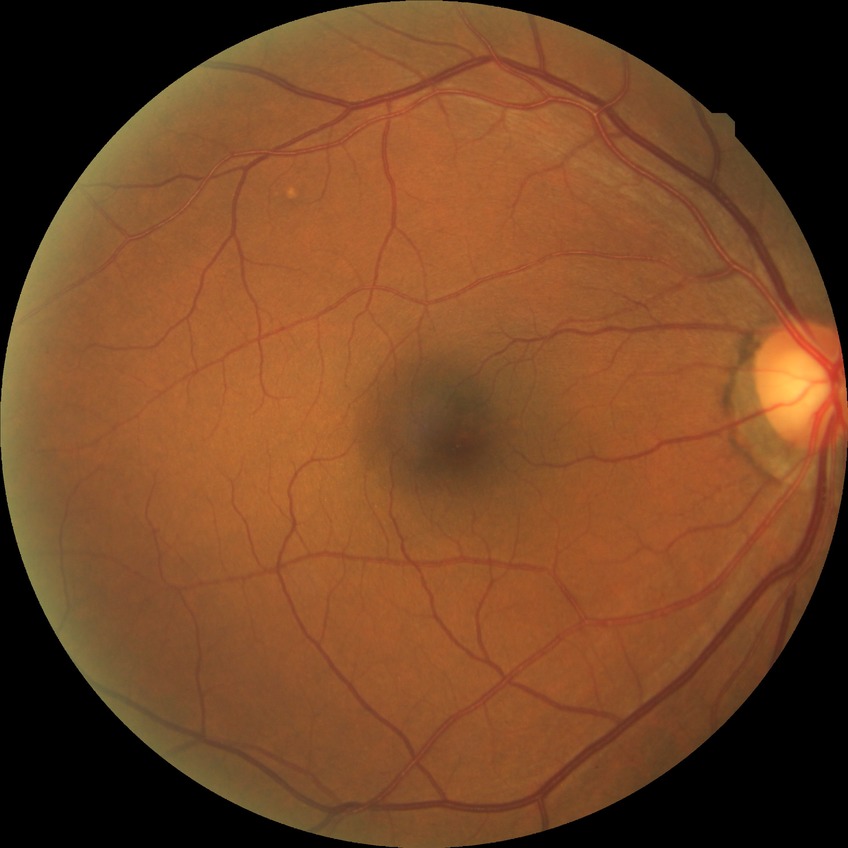

{"davis_grade": "no diabetic retinopathy (NDR)"}